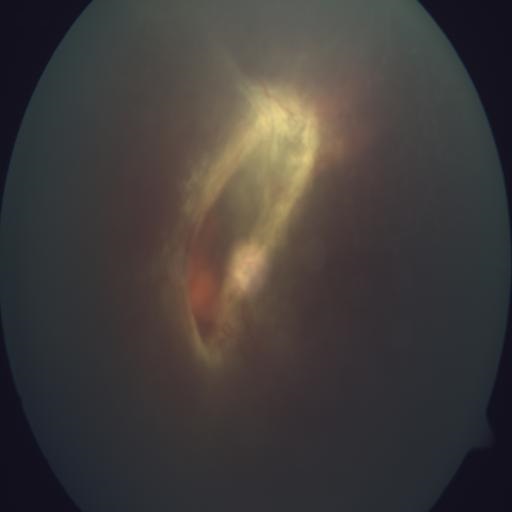 Pathology: retinal tear (RTR).